640x480. 130° field of view (Clarity RetCam 3). Pediatric wide-field fundus photograph — 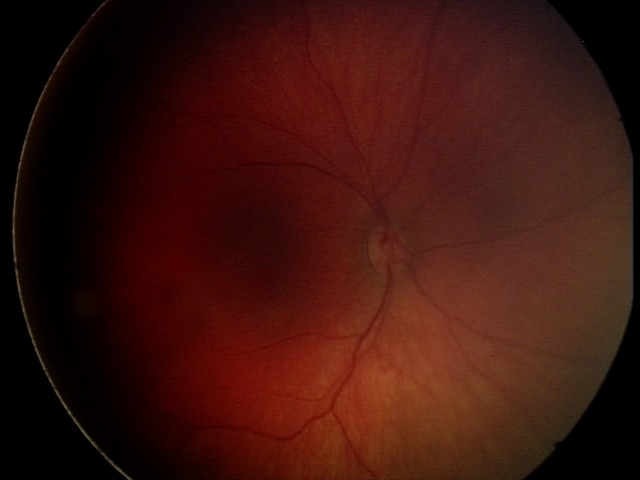 Screening examination consistent with retinal hemorrhages.